1240x1240px · wide-field fundus photograph of an infant — 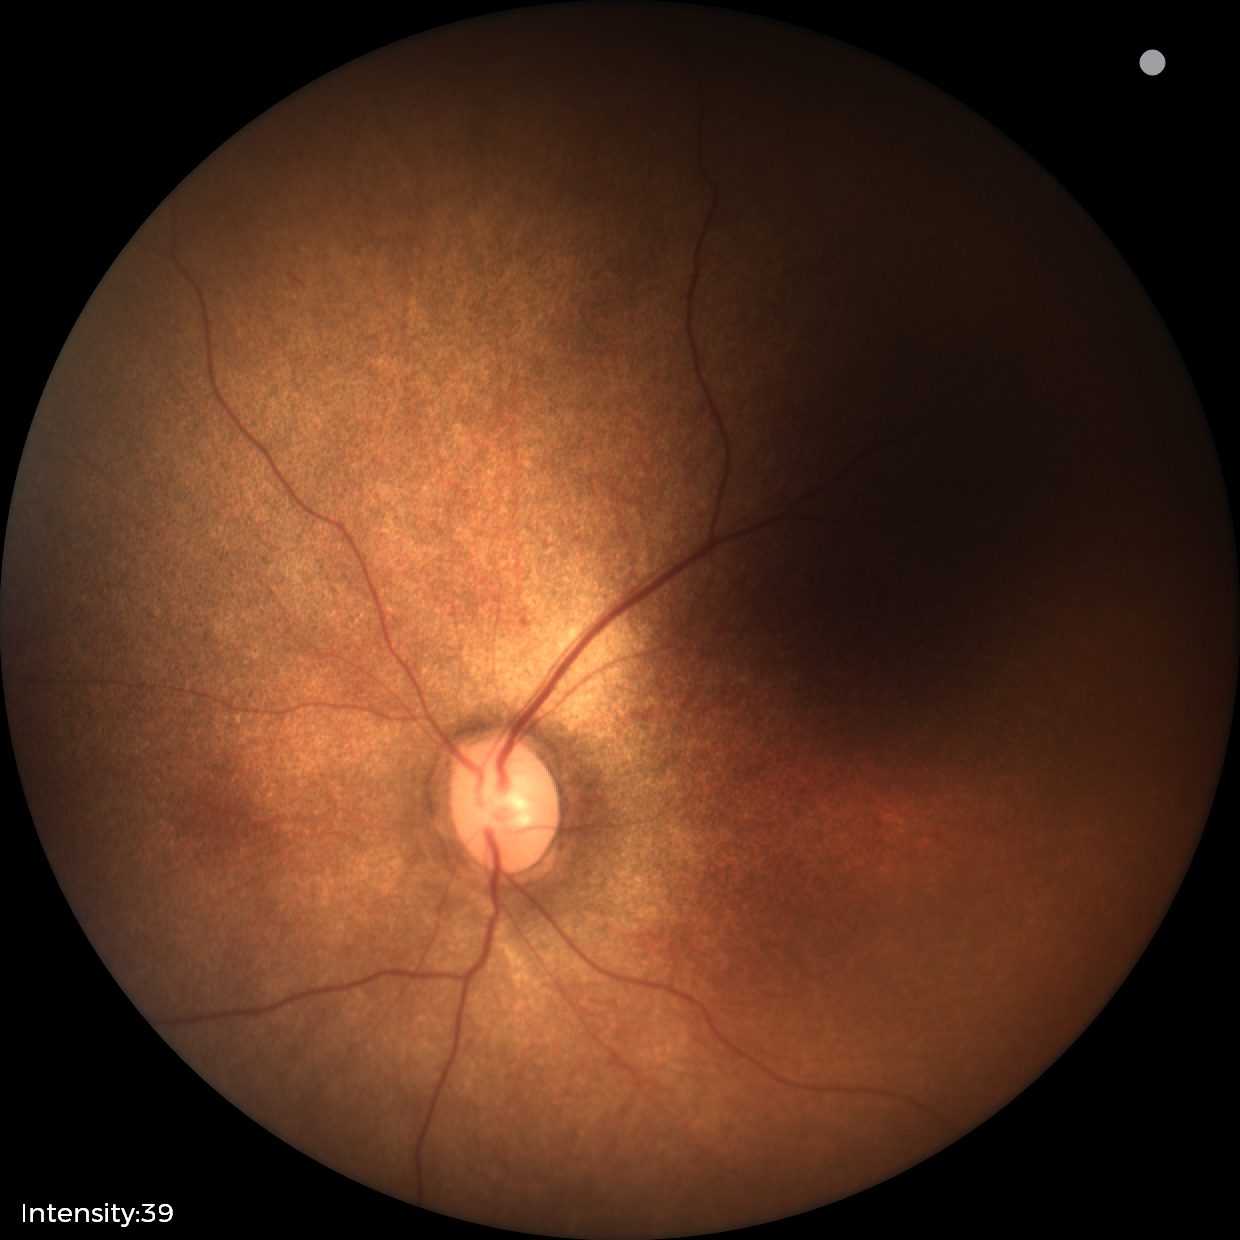
Screening examination with no abnormal retinal findings.